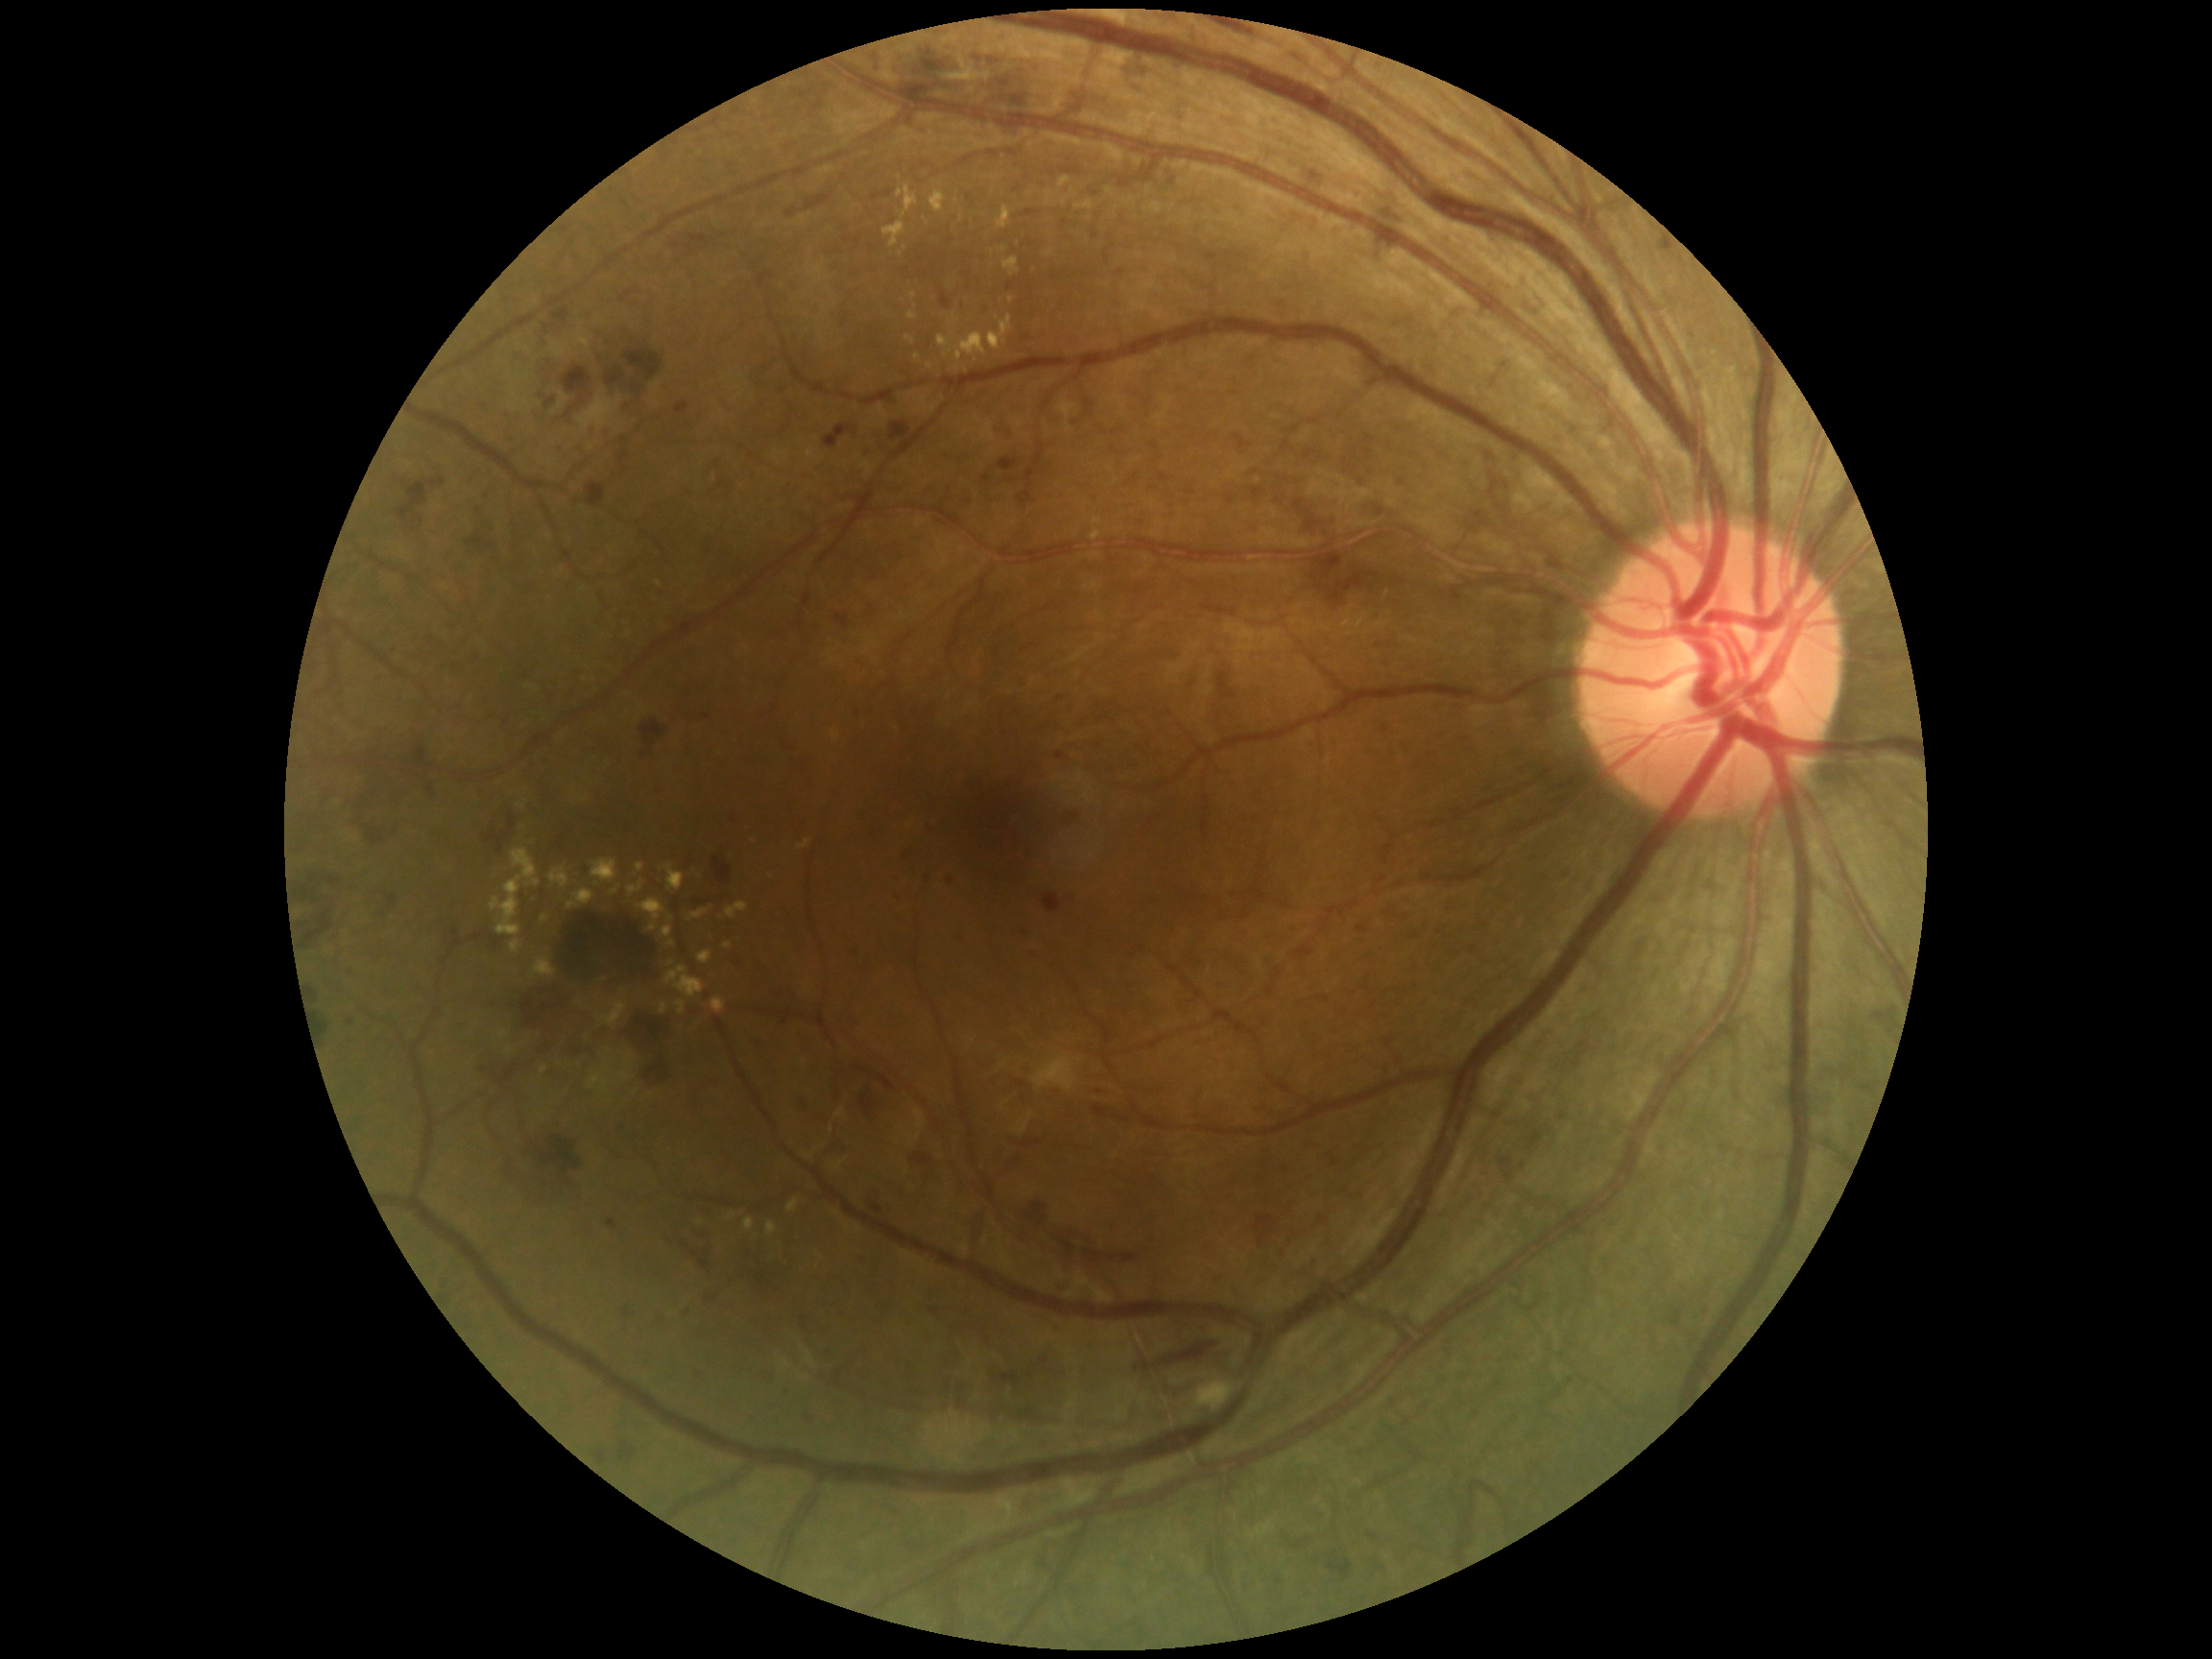
DR severity is grade 3 — more than 20 intraretinal hemorrhages in each of 4 quadrants, definite venous beading in 2 or more quadrants, or prominent intraretinal microvascular abnormalities in 1 or more quadrants, with no signs of proliferative retinopathy. HEs include those at box=[541, 357, 560, 386], box=[505, 1147, 579, 1204], box=[748, 1037, 763, 1054], box=[486, 830, 504, 854], box=[855, 1064, 897, 1093], box=[1042, 892, 1063, 914], box=[1061, 1279, 1077, 1300], box=[428, 784, 435, 797], box=[714, 846, 733, 884], box=[836, 614, 849, 630], box=[999, 458, 1021, 471], box=[974, 56, 982, 61], box=[557, 367, 593, 423], box=[868, 1192, 886, 1214], box=[1135, 1343, 1218, 1374], box=[857, 1090, 887, 1120], box=[706, 1287, 719, 1305], box=[598, 1451, 608, 1464]. EXs include those at box=[1059, 178, 1070, 188], box=[533, 959, 558, 978], box=[627, 880, 646, 897], box=[637, 863, 645, 873], box=[727, 1214, 736, 1221], box=[744, 1218, 754, 1233], box=[949, 314, 960, 326], box=[897, 185, 918, 219], box=[510, 940, 523, 954], box=[930, 190, 947, 212], box=[600, 1002, 627, 1025], box=[665, 966, 705, 998], box=[662, 927, 672, 939]. Additional small EXs near point(958, 370), point(545, 919), point(997, 318), point(966, 371), point(1011, 301), point(544, 1072). MAs include those at box=[605, 431, 613, 438], box=[607, 1221, 616, 1229], box=[1154, 487, 1161, 495], box=[960, 302, 963, 311], box=[783, 1385, 789, 1393], box=[1056, 754, 1064, 760], box=[1311, 173, 1319, 180], box=[851, 947, 860, 951], box=[848, 1014, 858, 1025], box=[929, 1310, 941, 1317]. Additional small MAs near point(986, 310), point(662, 790), point(1099, 1092), point(1361, 483), point(623, 1130), point(627, 408), point(739, 965), point(483, 1070), point(1314, 1264).